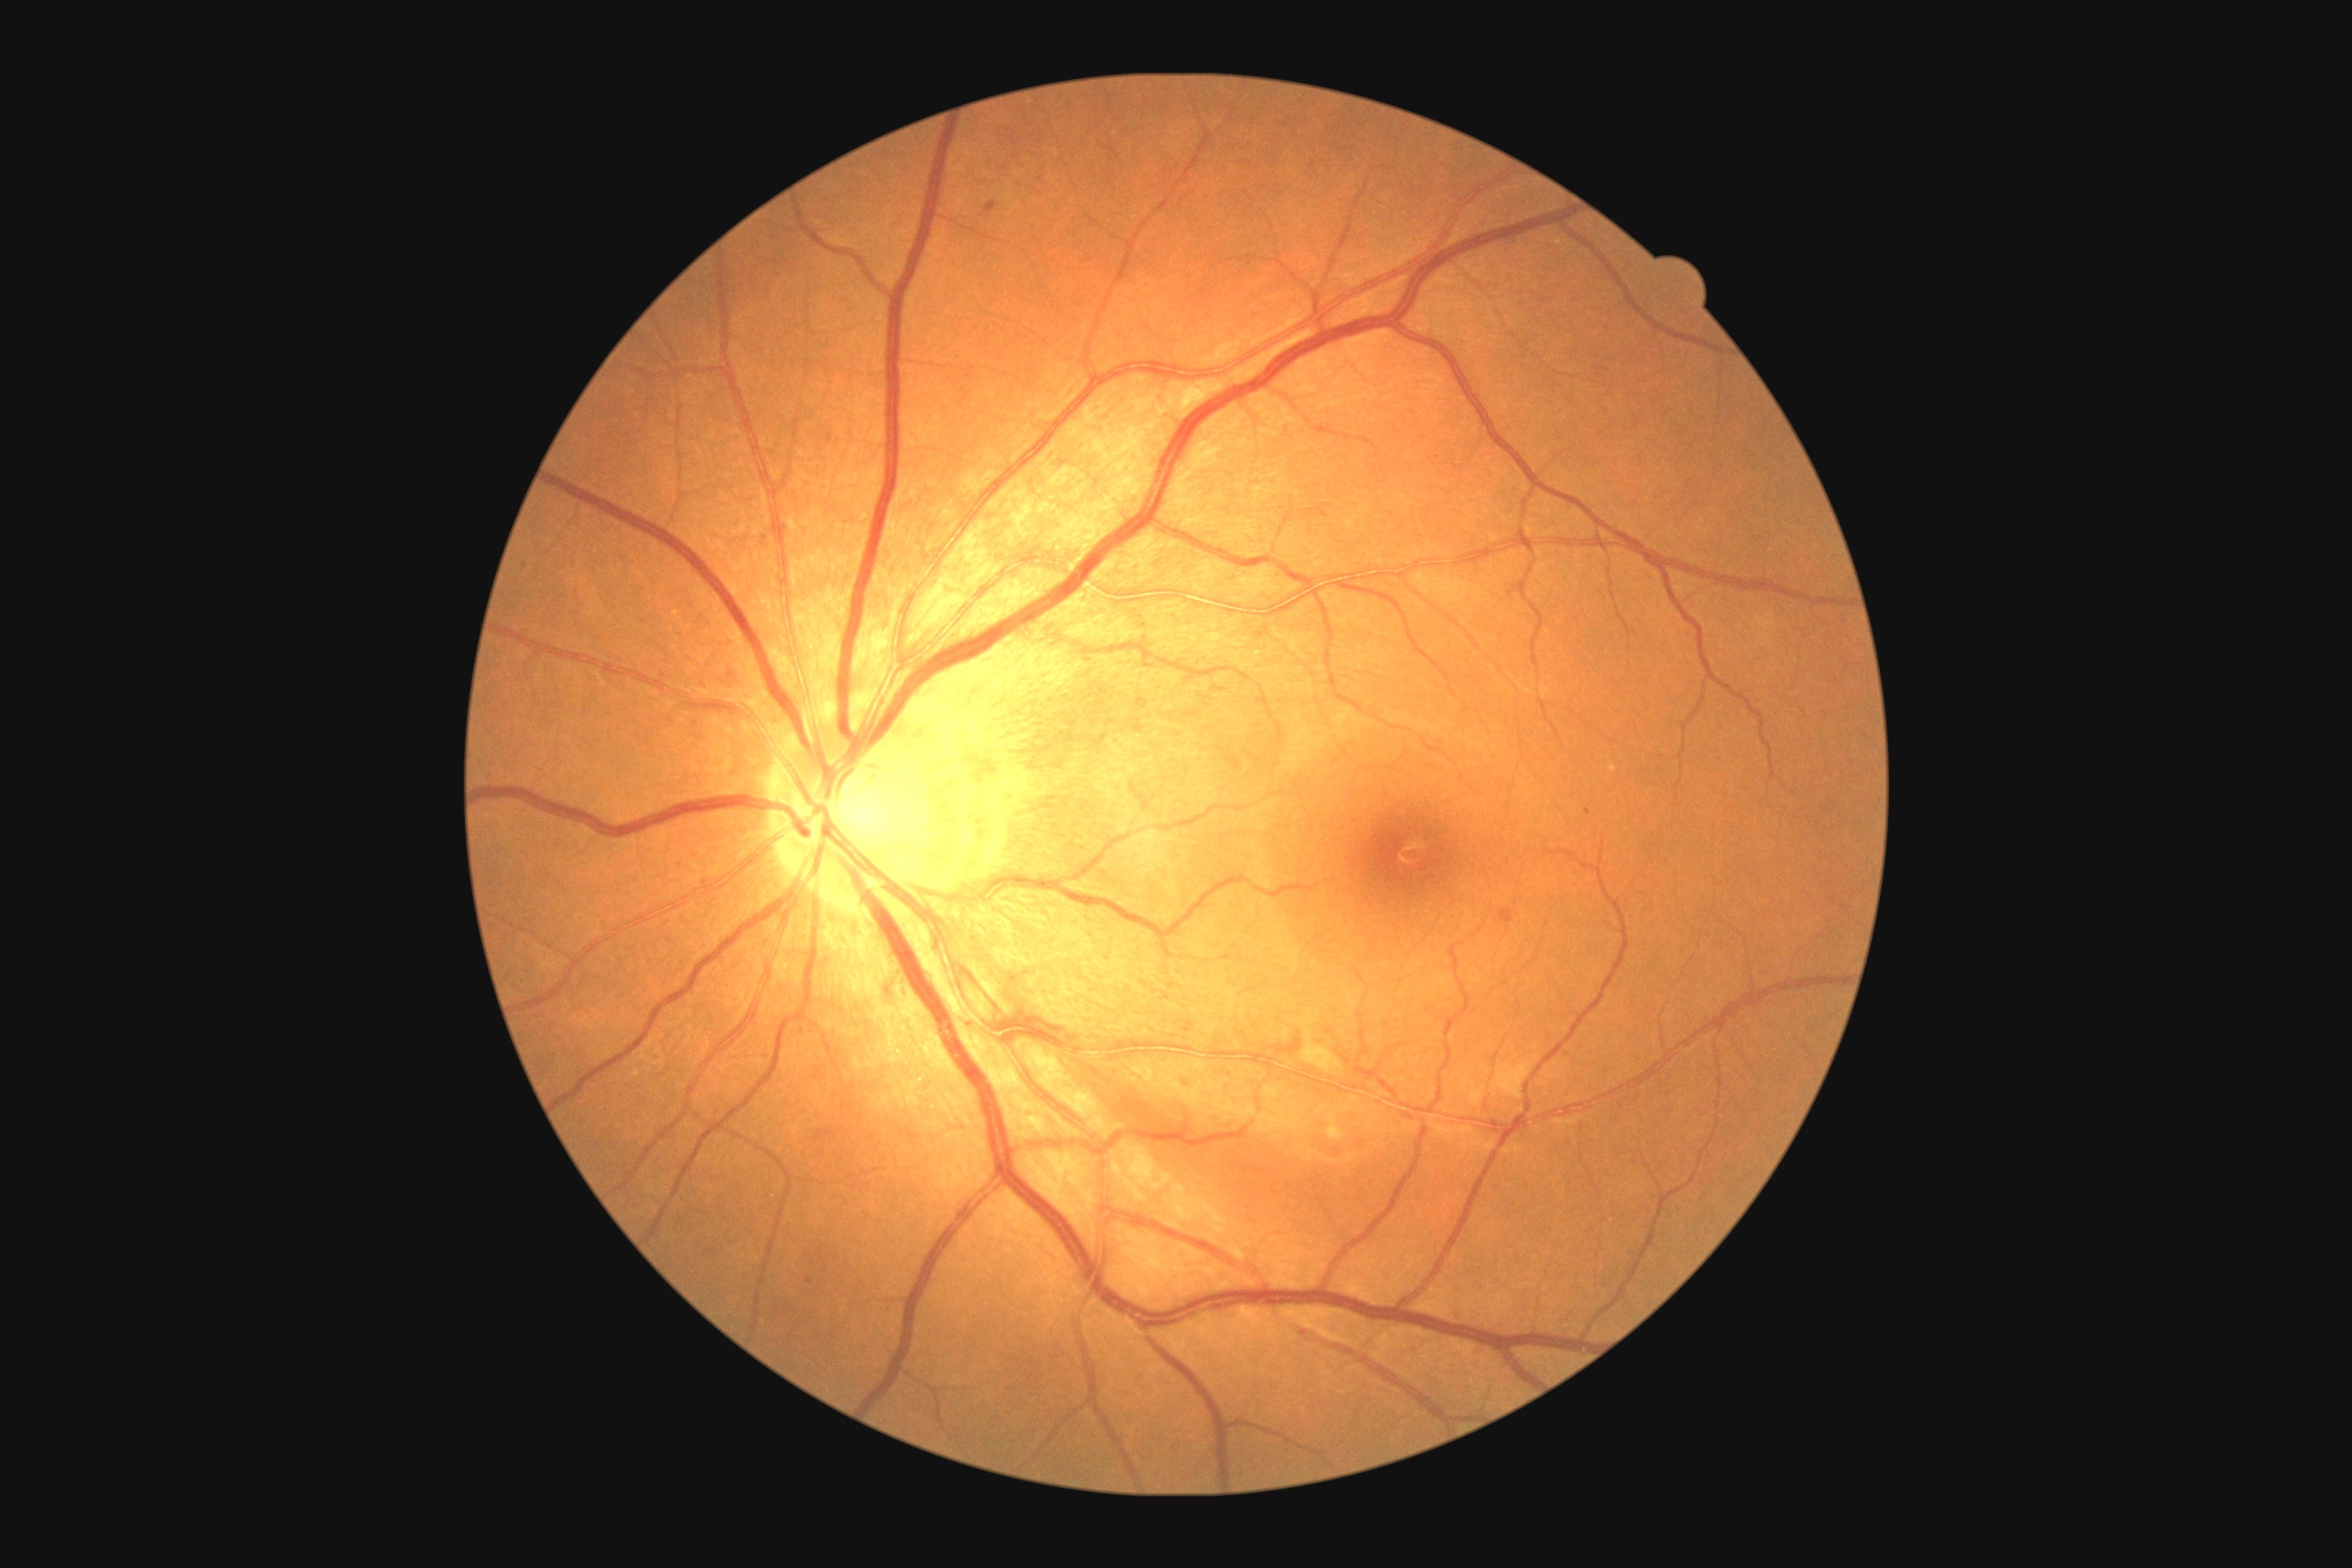

Diabetic retinopathy severity: moderate NPDR (grade 2). DR class: non-proliferative diabetic retinopathy.